640 x 480 pixels. Wide-field fundus photograph from neonatal ROP screening
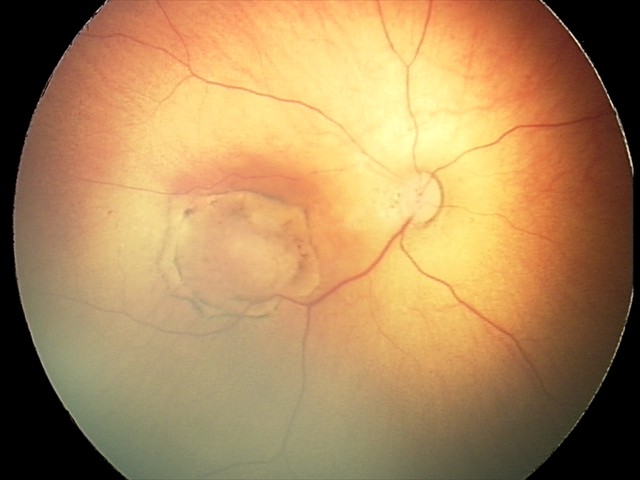
Assessment: toxoplasmosis chorioretinitis.